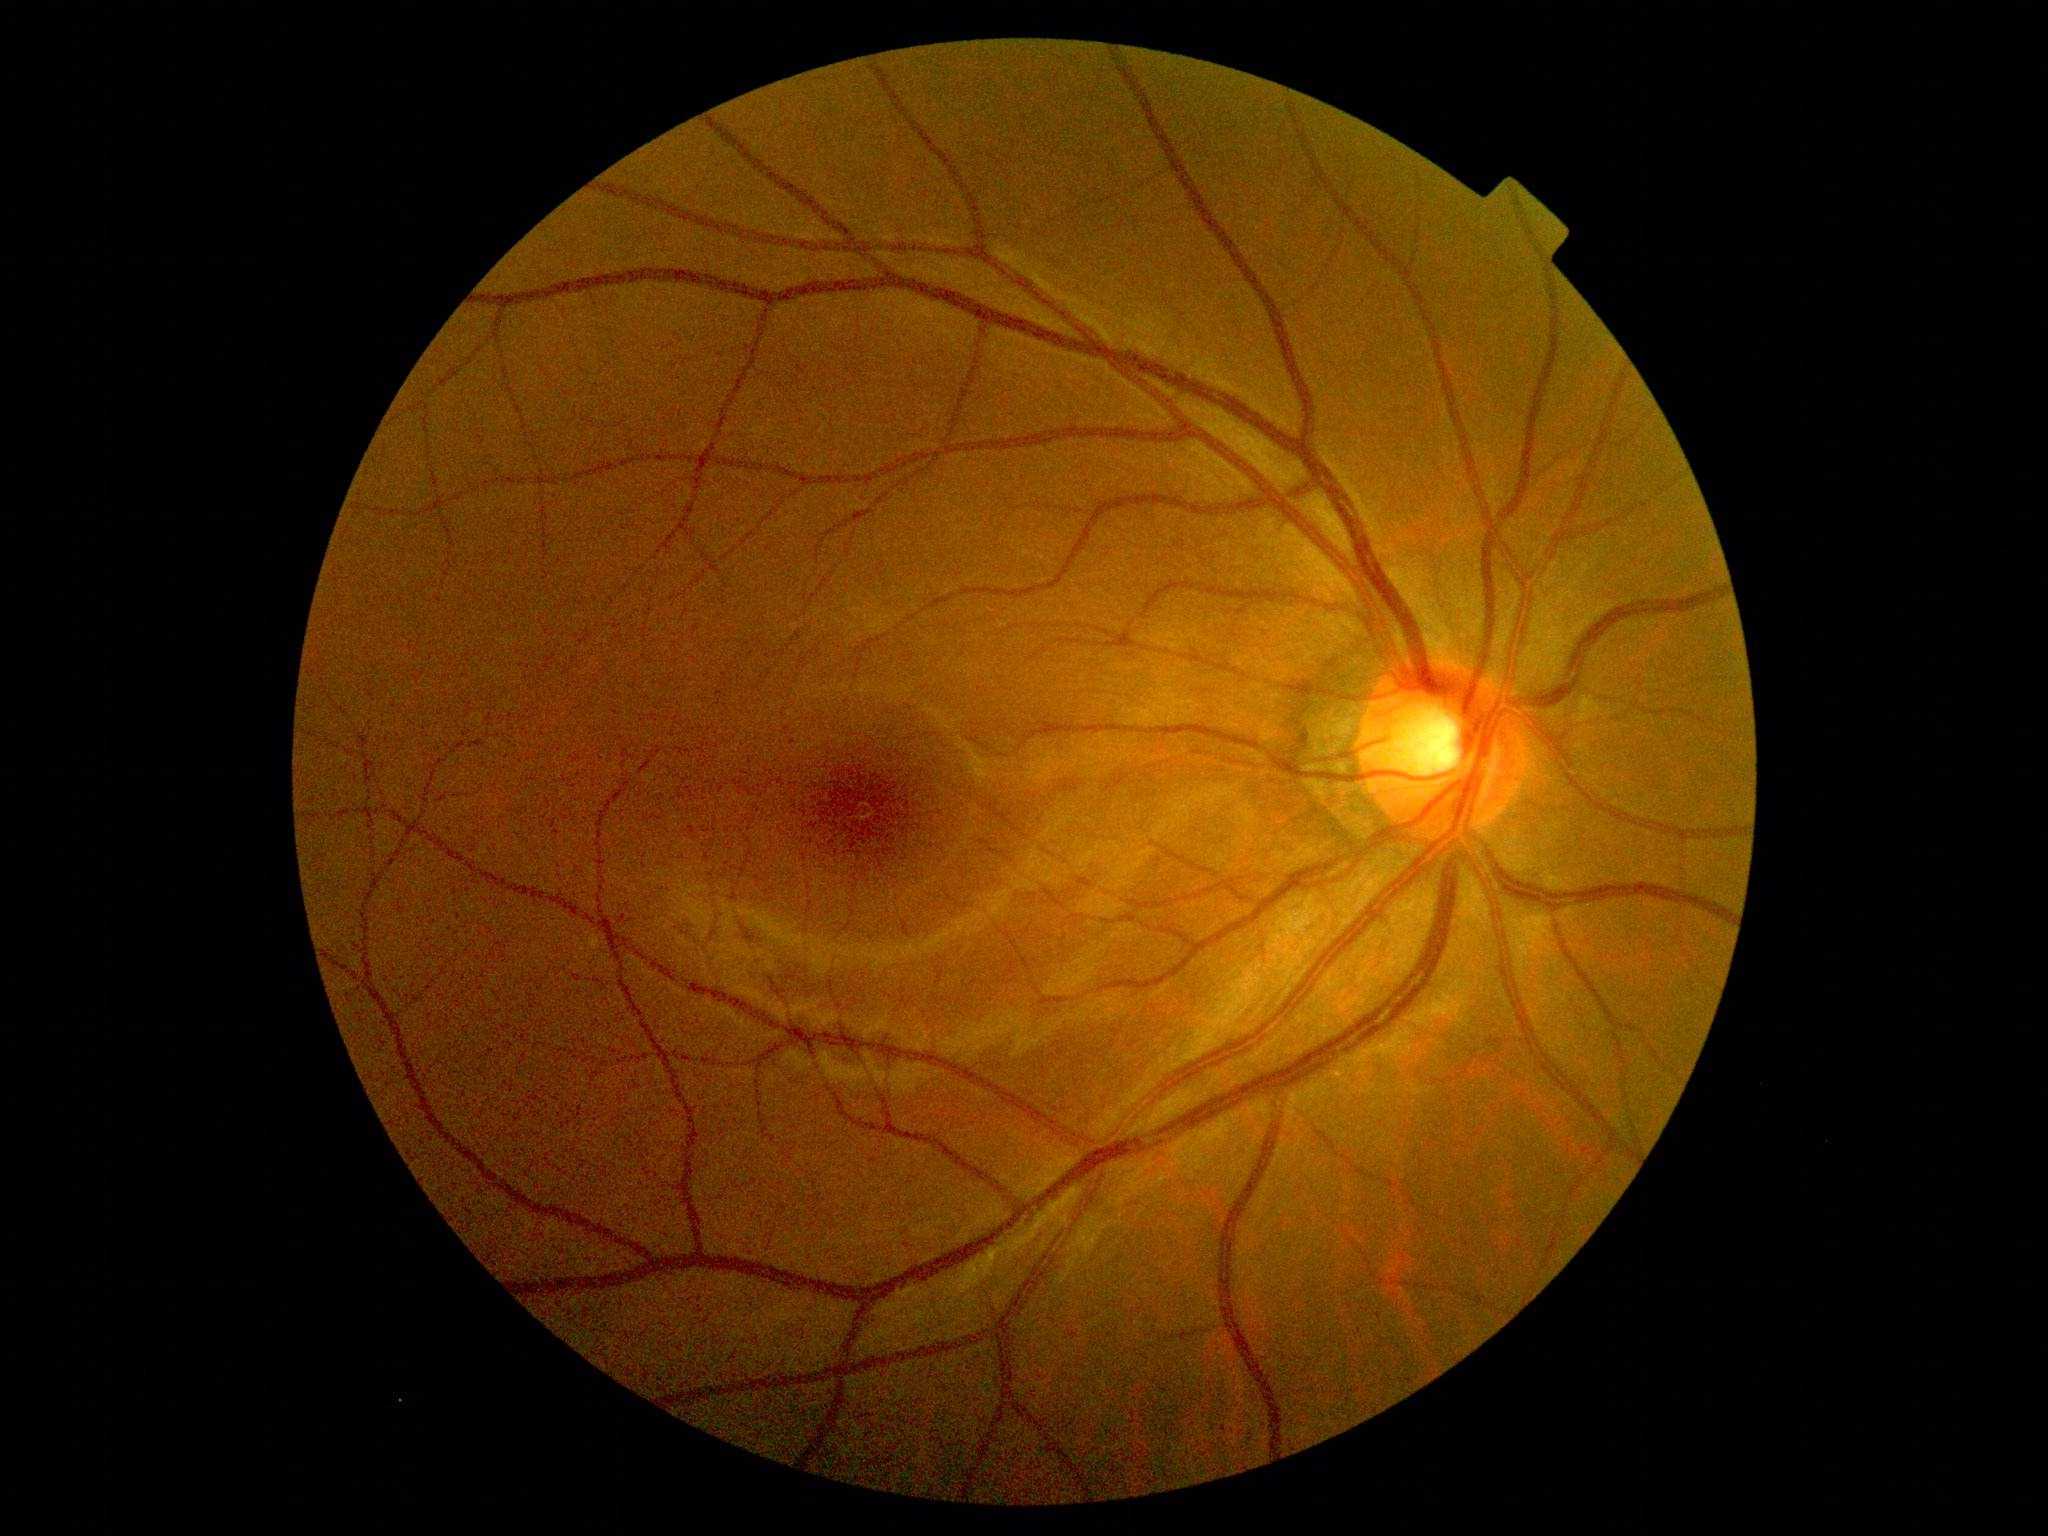

DR grade is 1 (mild NPDR).
Disease class: non-proliferative diabetic retinopathy.